2048x1536px: 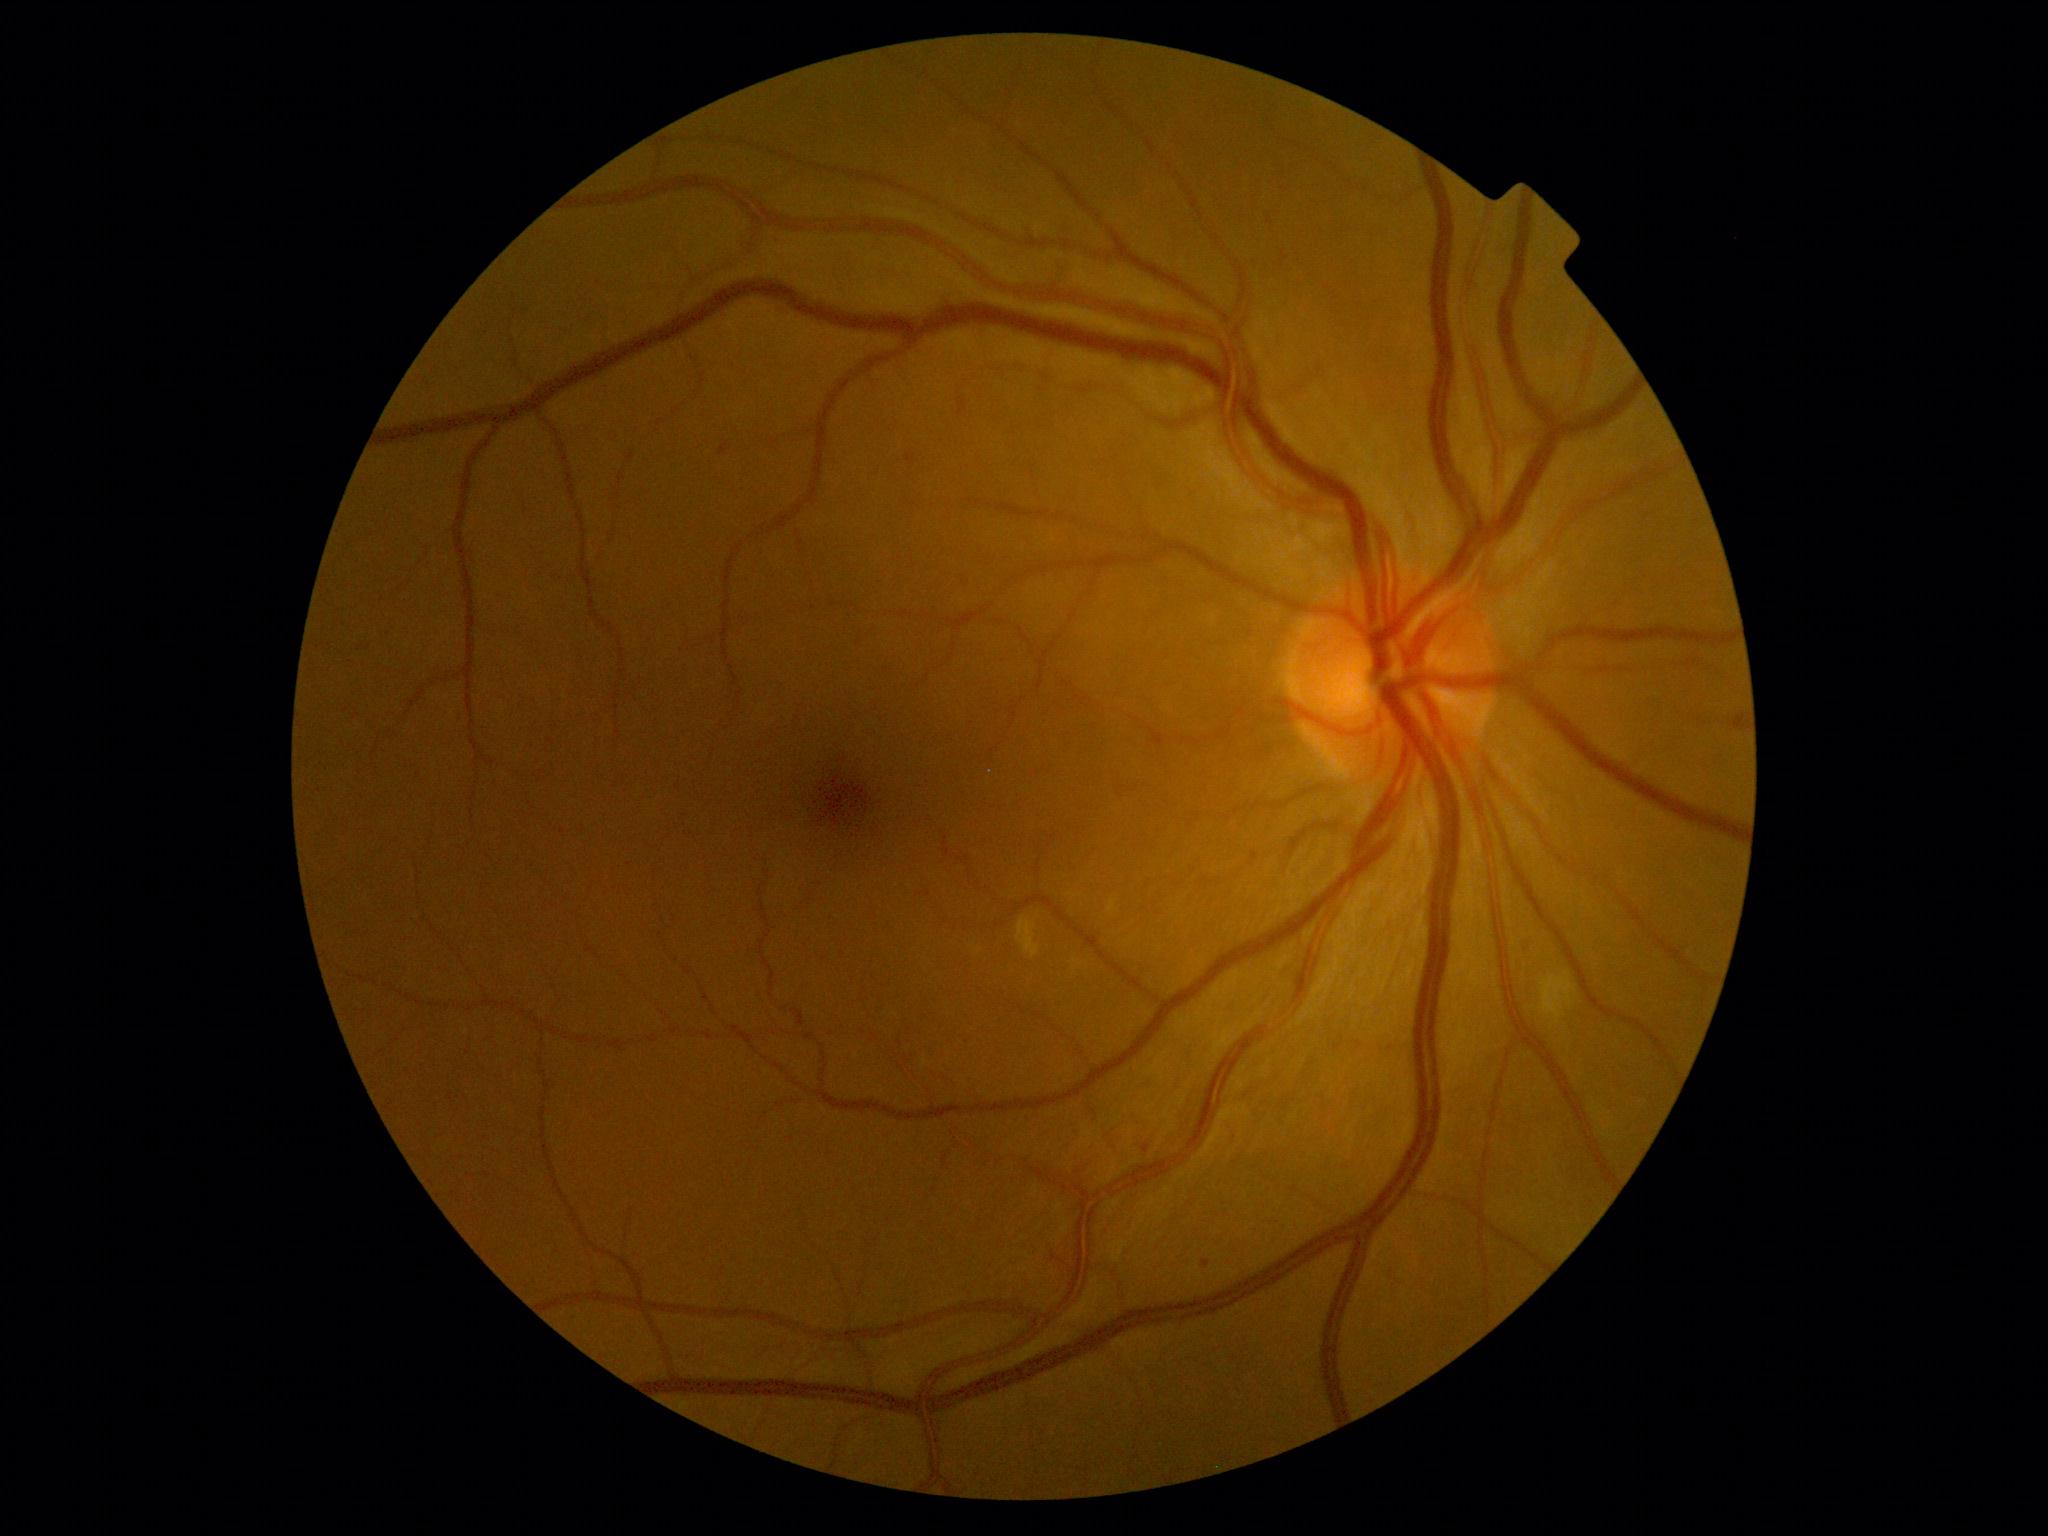

DR grade is 2.